640 by 480 pixels. RetCam wide-field infant fundus image: 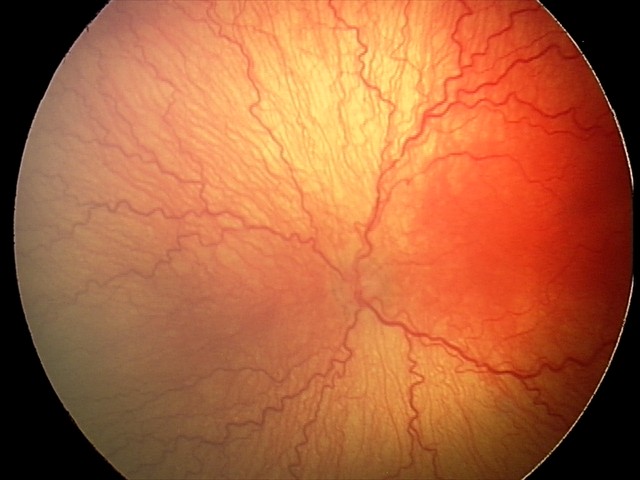

Screening examination consistent with aggressive retinopathy of prematurity (A-ROP).